Acquired with a Topcon TRC-50DX; 50° field of view; color fundus photograph; central posterior field:
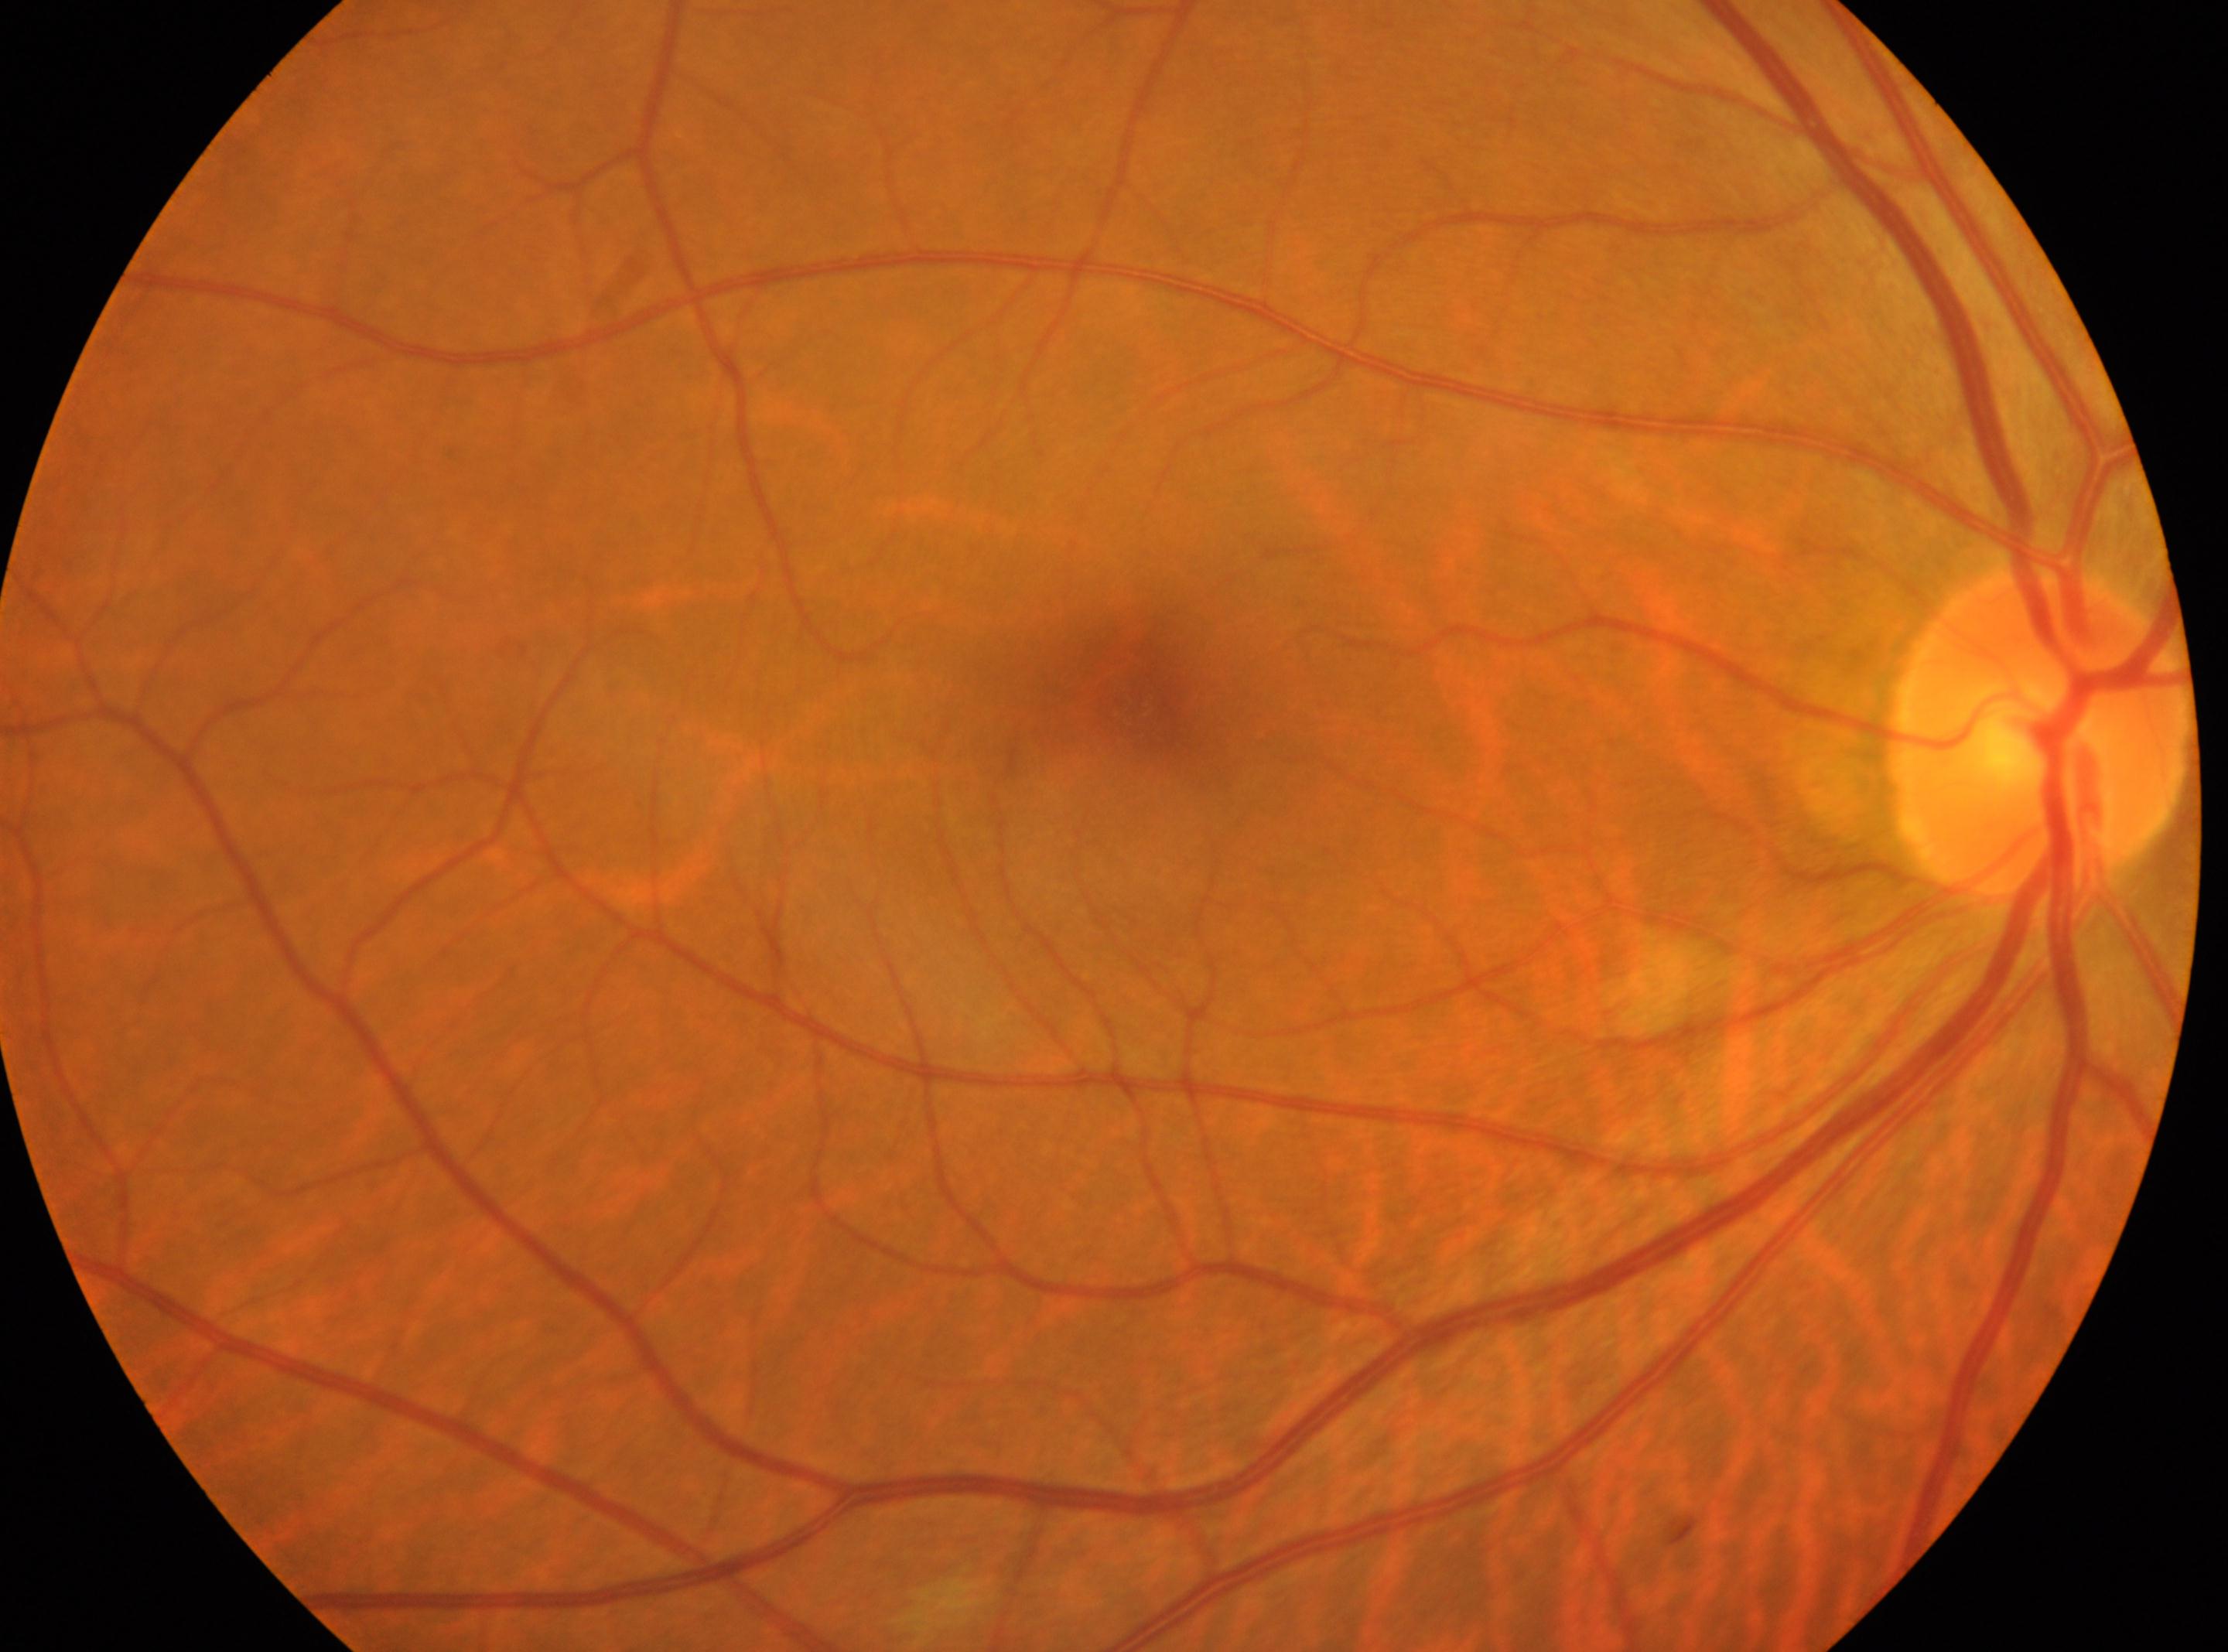
{"fovea": "1140, 698", "optic_disc": "2038, 735", "dr_grade": "0", "eye": "right", "dr_impression": "No signs of diabetic retinopathy"}